Phoenix ICON wide-field infant fundus image.
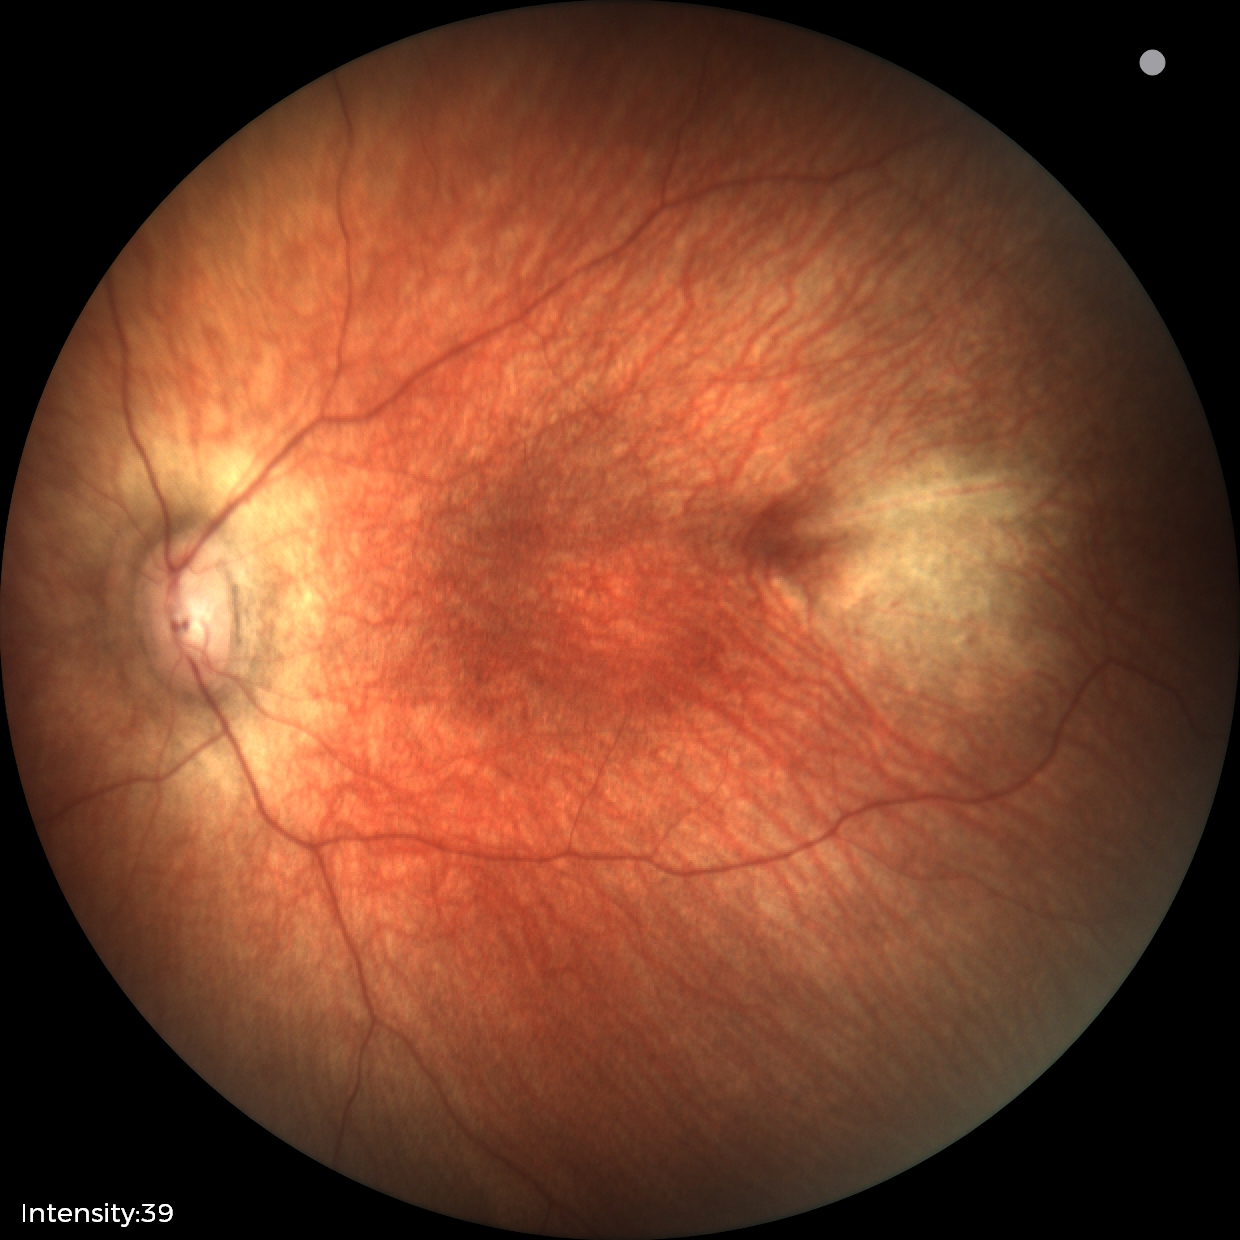

Q: What is the diagnosis from this examination?
A: physiological appearance with no retinal pathology